Retinal fundus photograph:
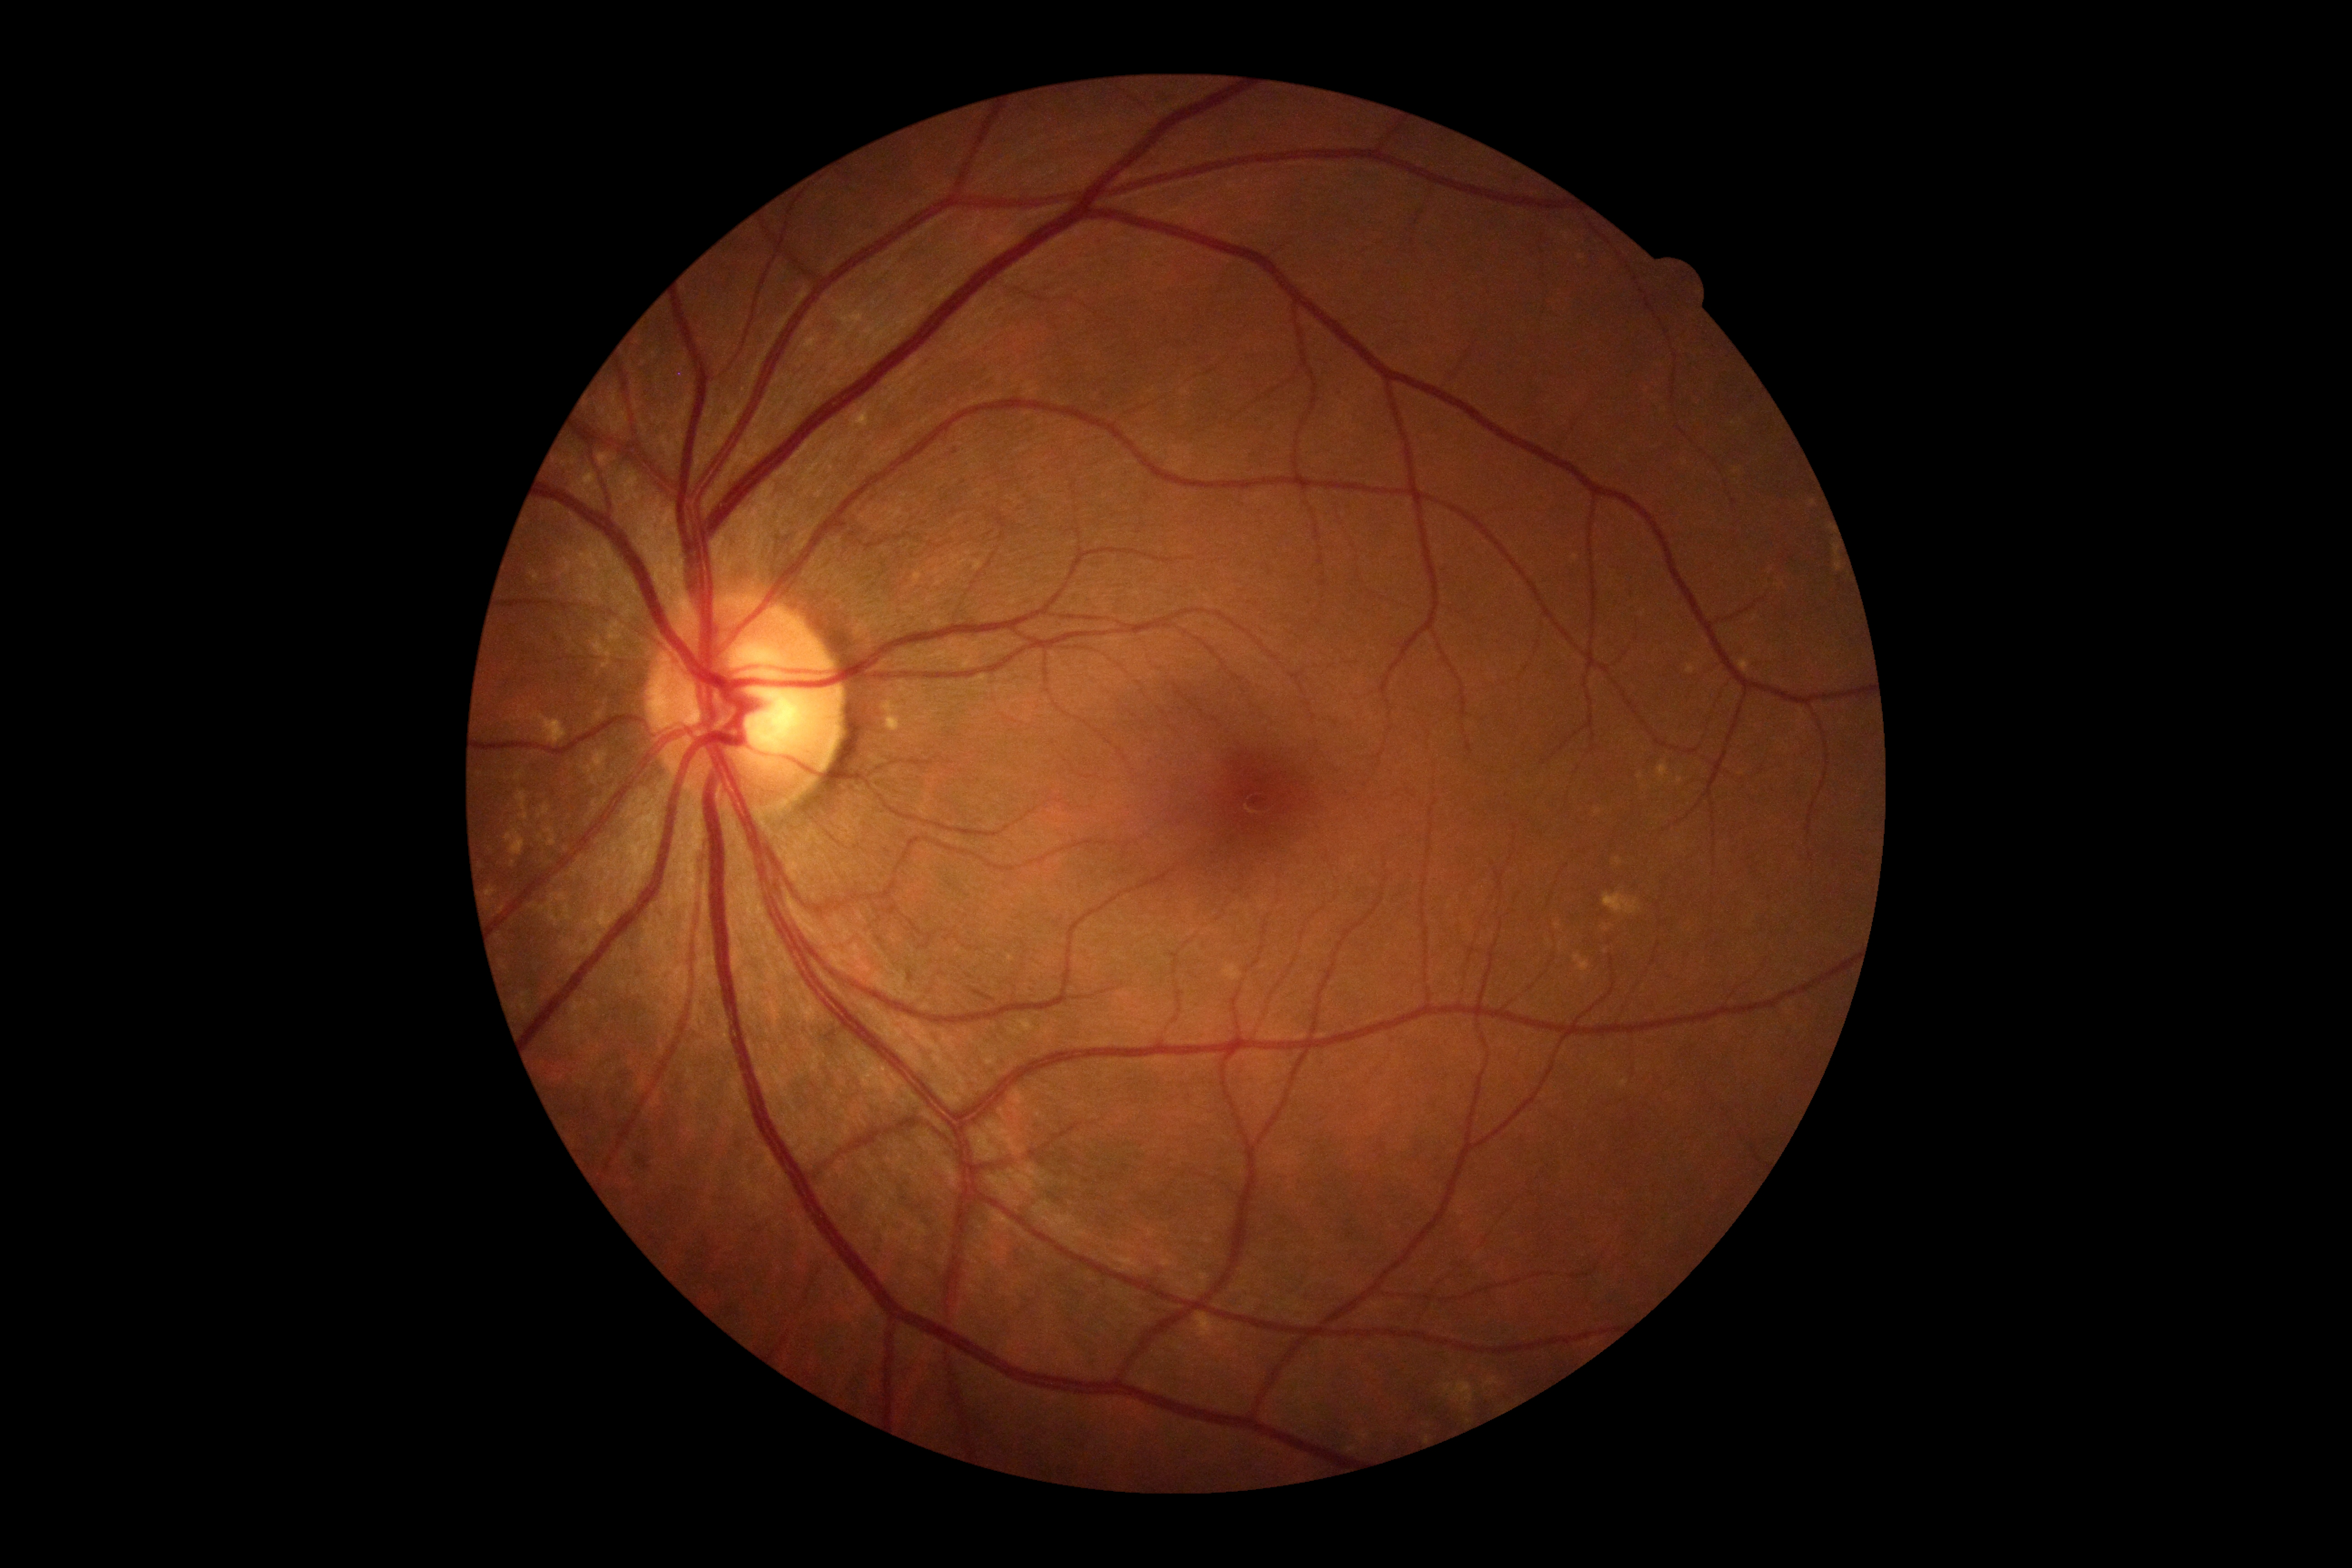
No apparent diabetic retinopathy. DR stage is no apparent retinopathy (grade 0).